Camera: Natus RetCam Envision (130° FOV) · infant wide-field retinal image: 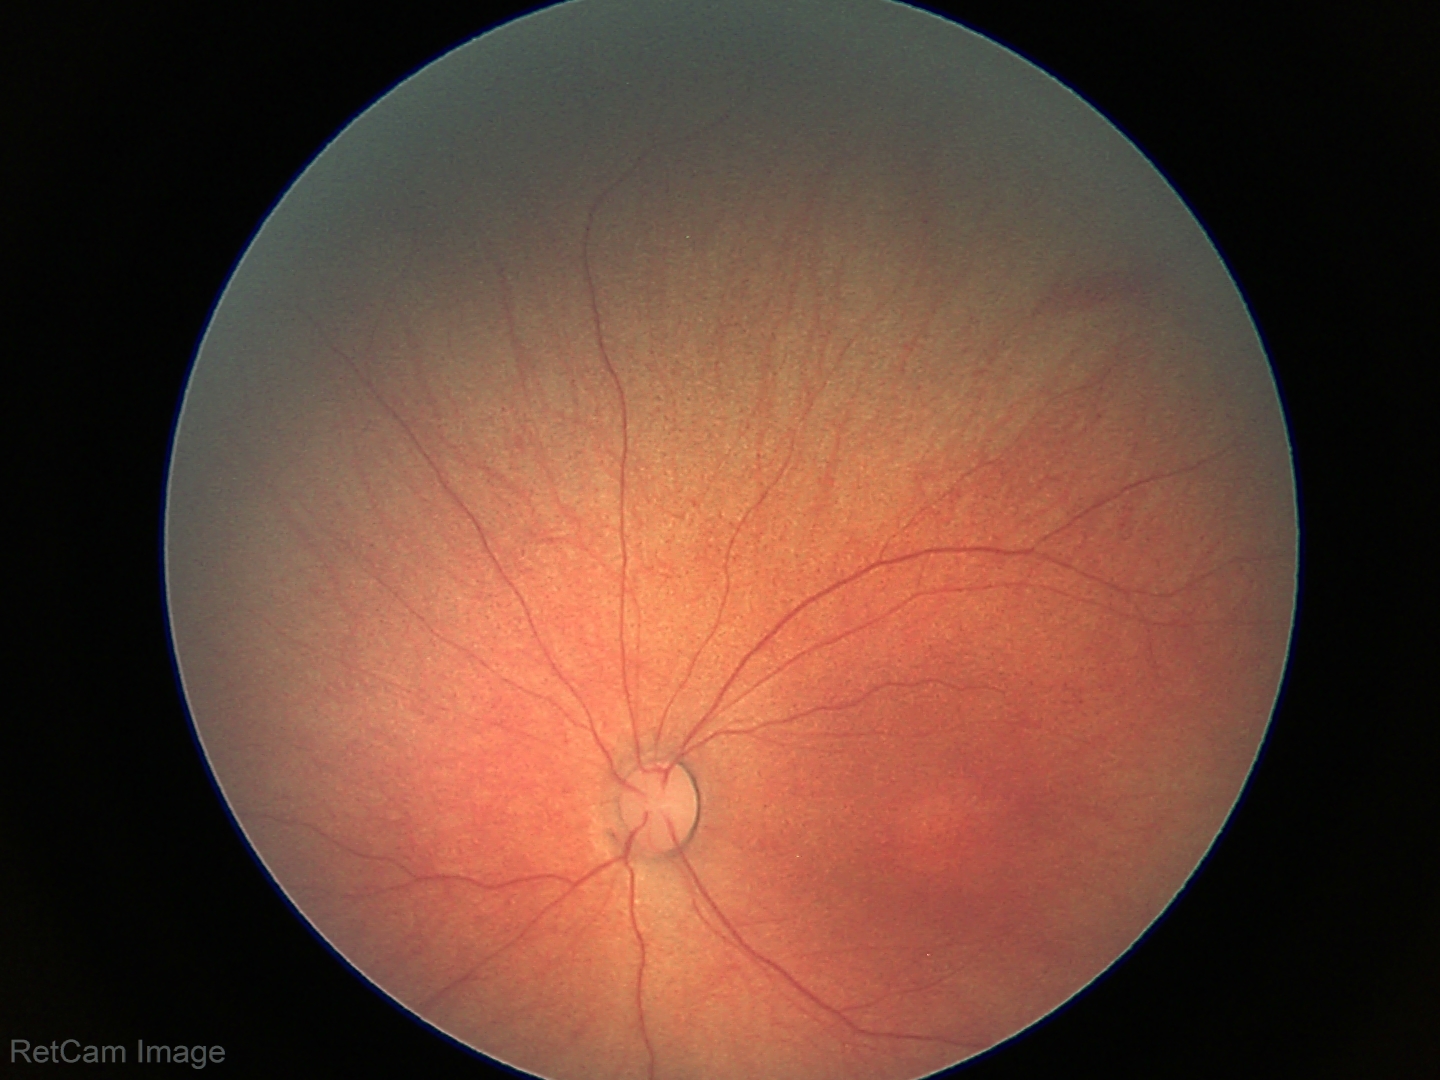

No retinal pathology identified on screening.